2048x1536 · retinal fundus photograph — 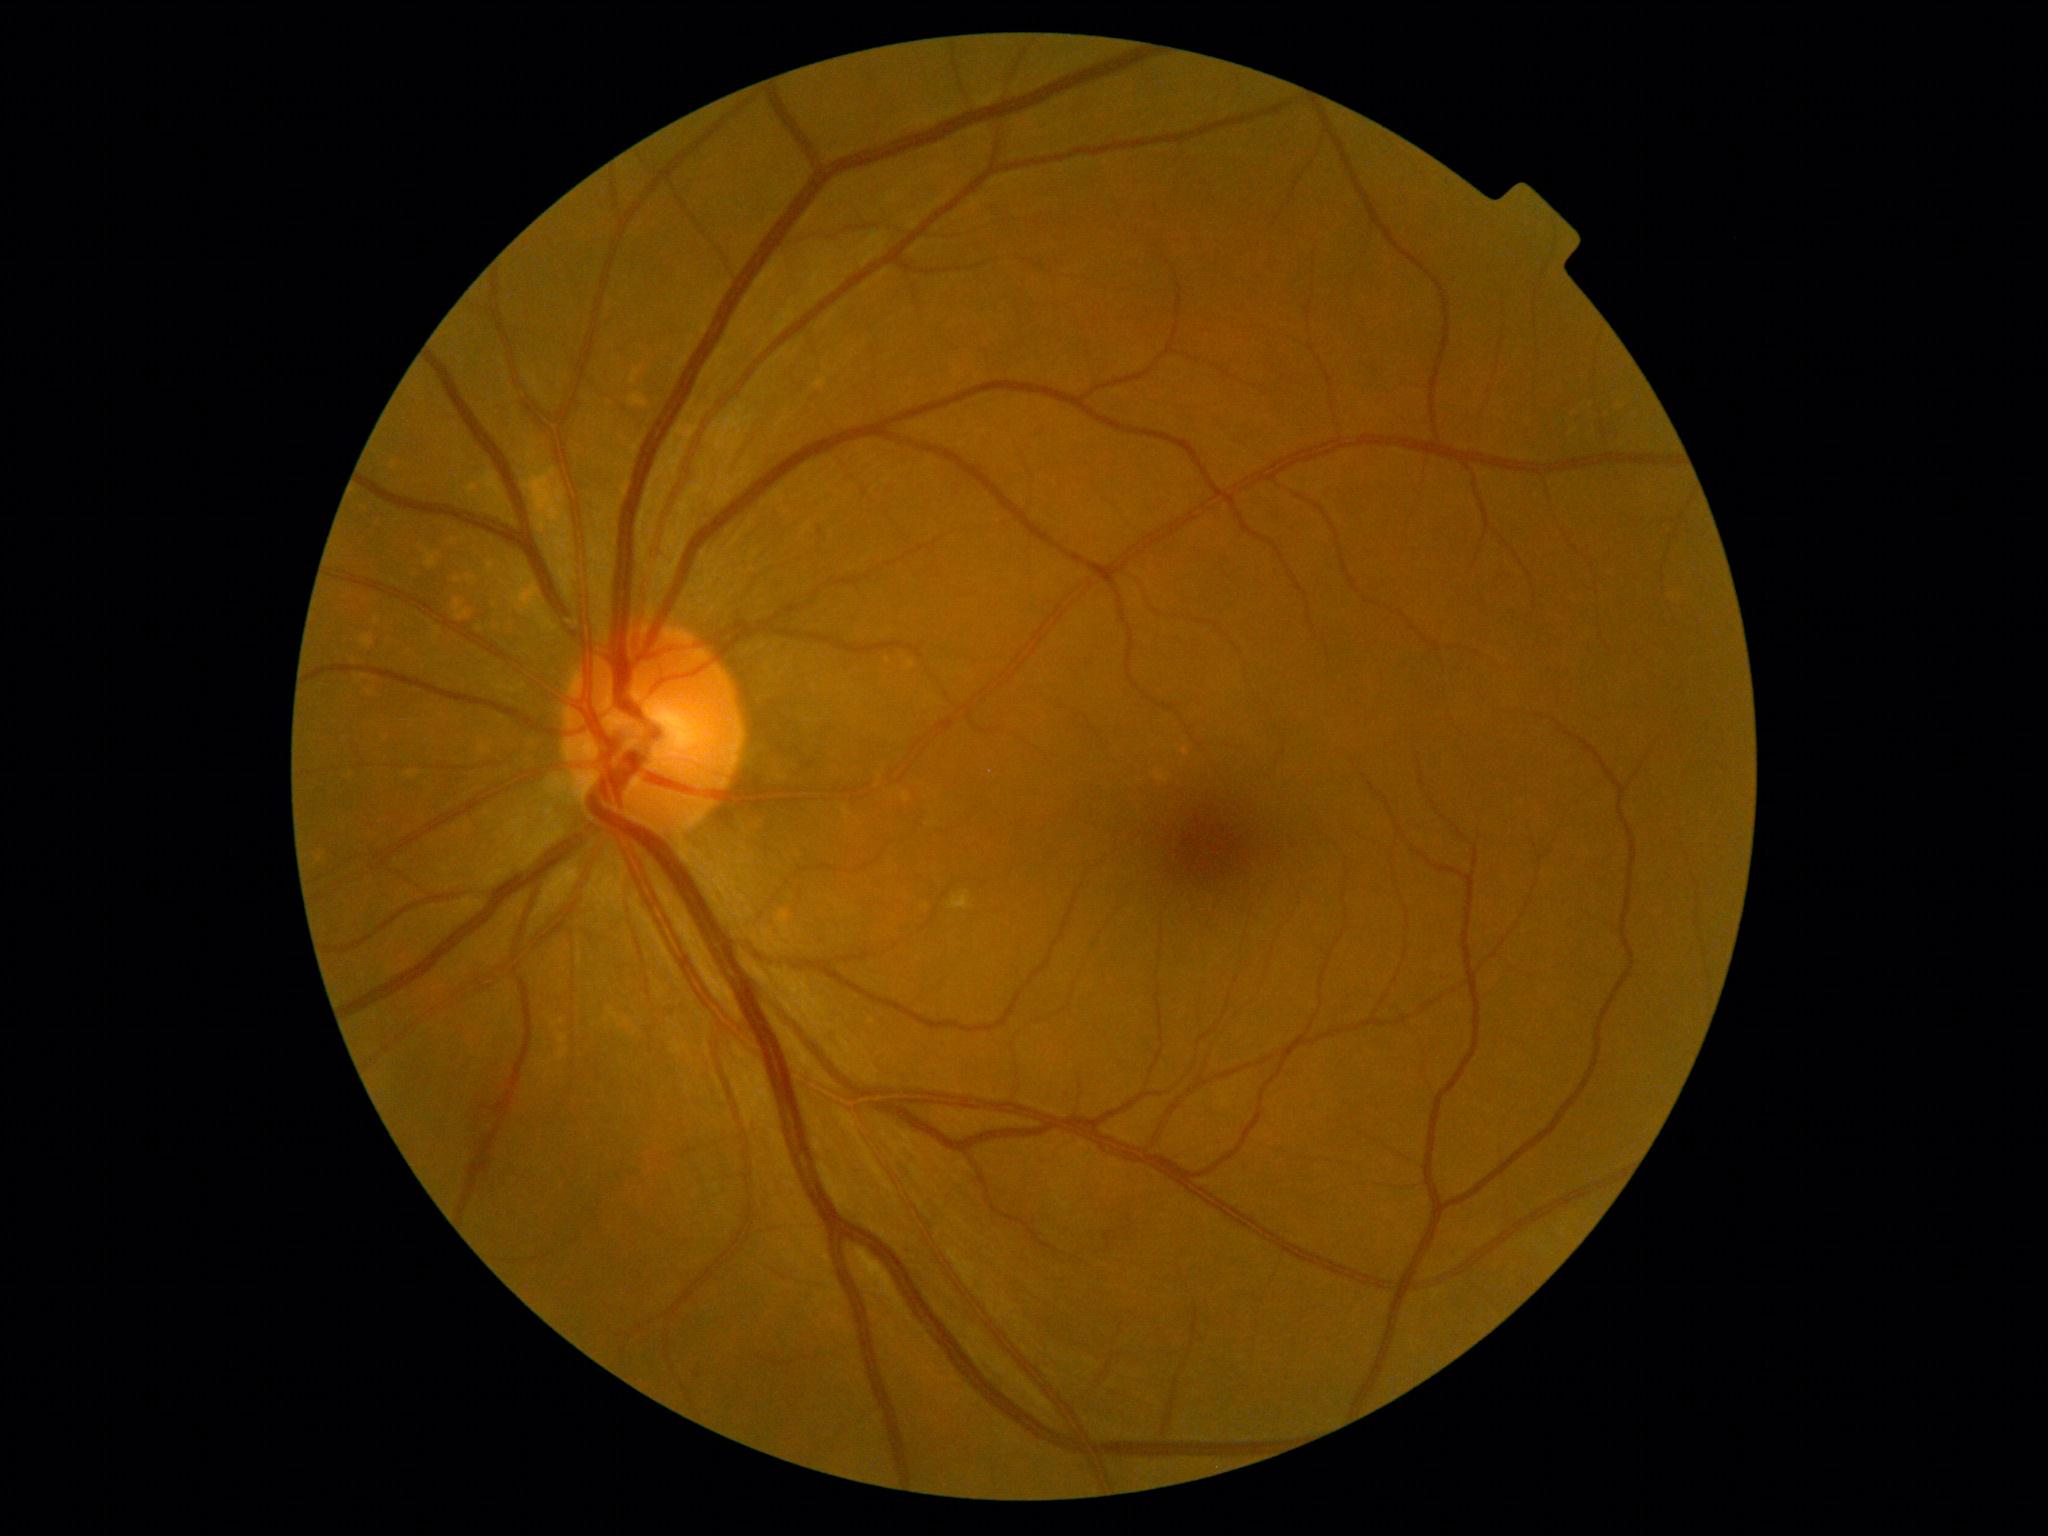
DR grade: 0 (no apparent retinopathy) — no visible signs of diabetic retinopathy | DR impression: no DR findings.